Posterior pole view, 50-degree field of view, captured after pupil dilation, image size 2228x1652
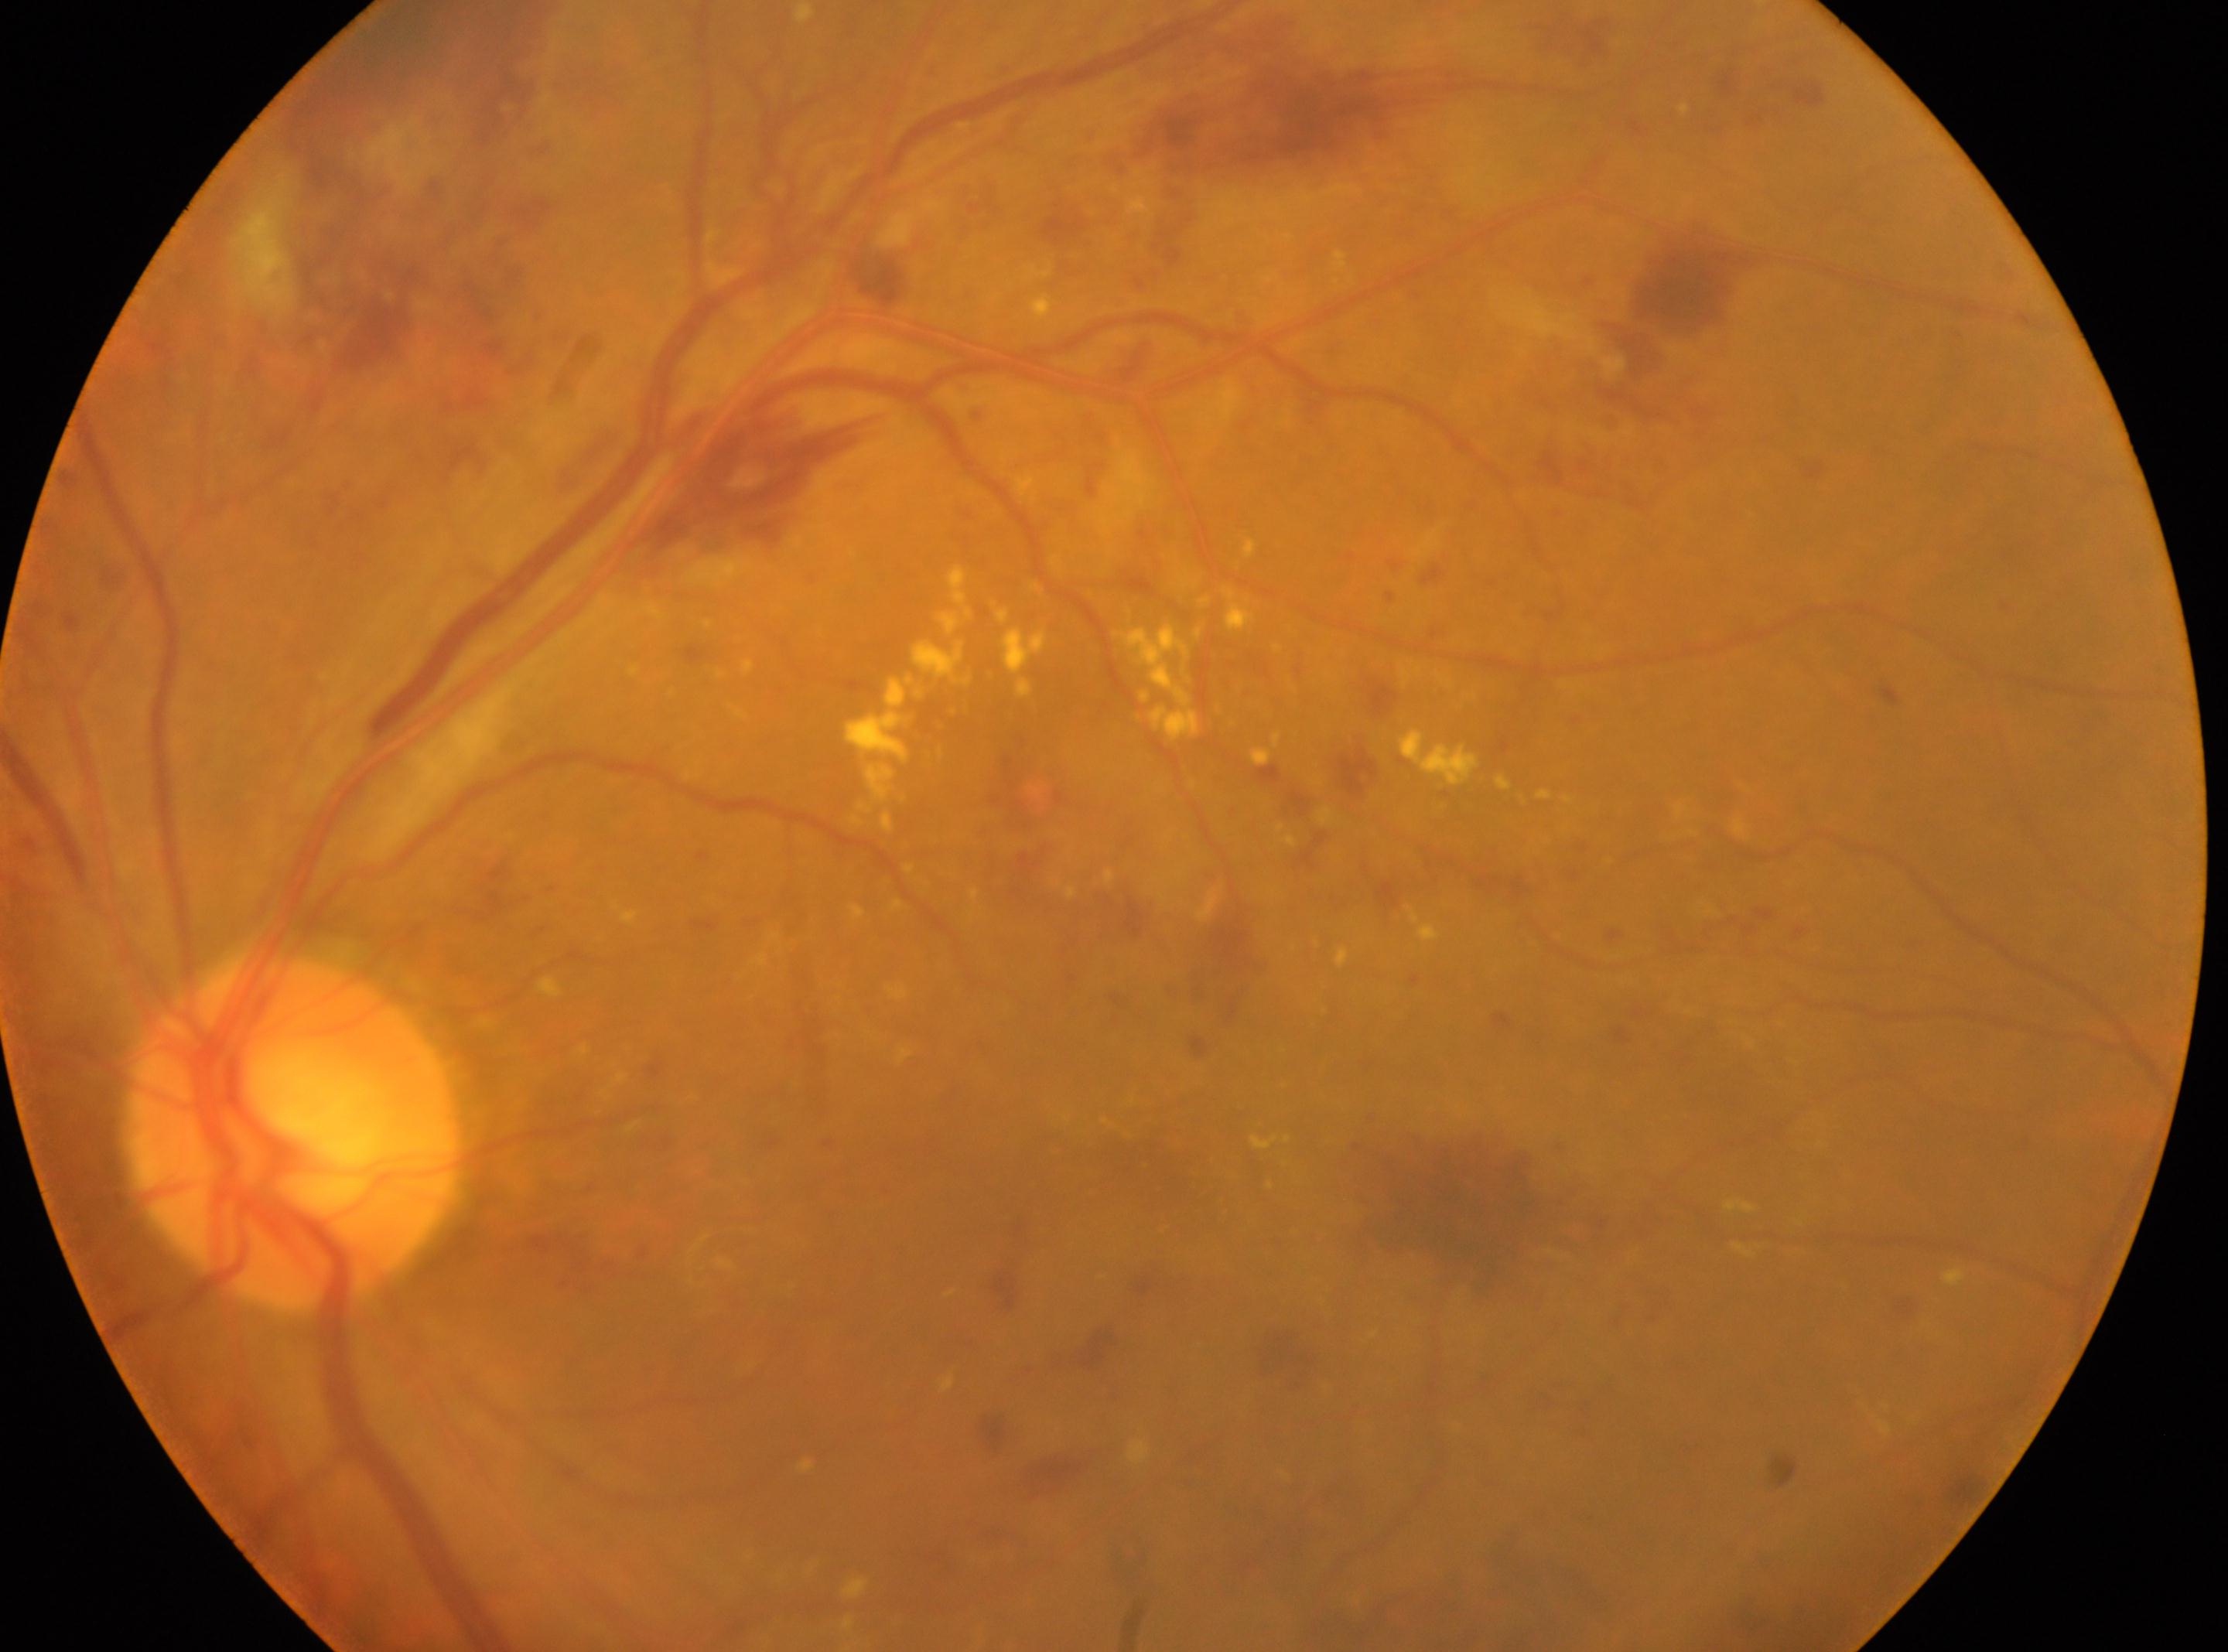 • diabetic retinopathy grade · 3
• fovea center · 1143px, 1168px
• ONH · 292px, 1137px
• laterality · the left eye